No pharmacologic dilation, graded on the modified Davis scale — 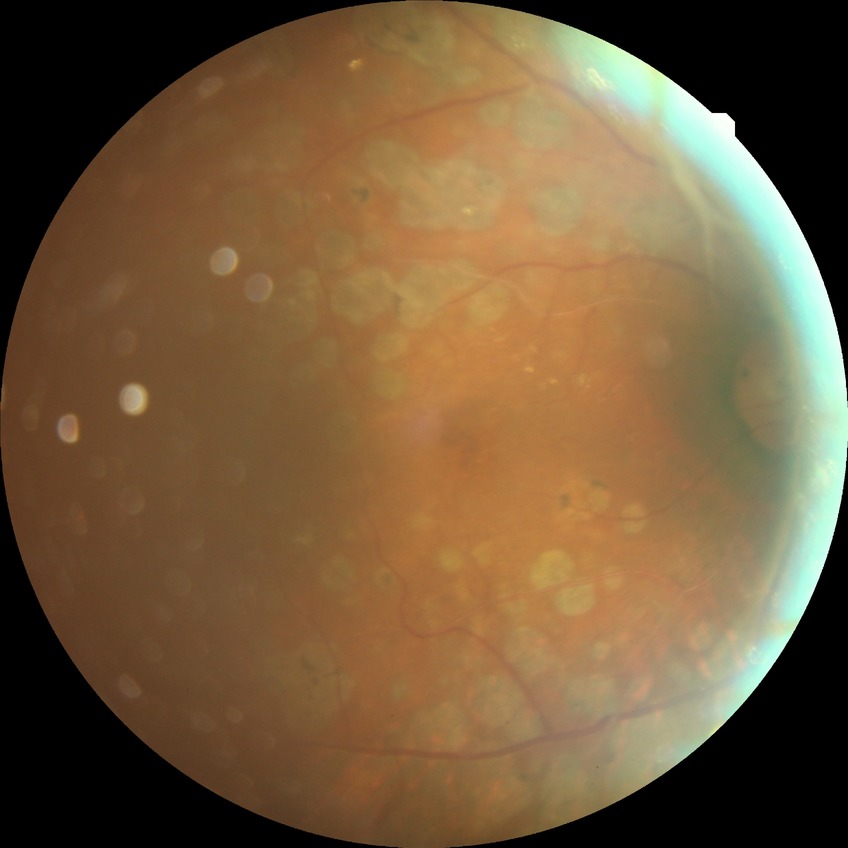 diabetic retinopathy (DR): proliferative diabetic retinopathy (PDR)